NIDEK AFC-230:
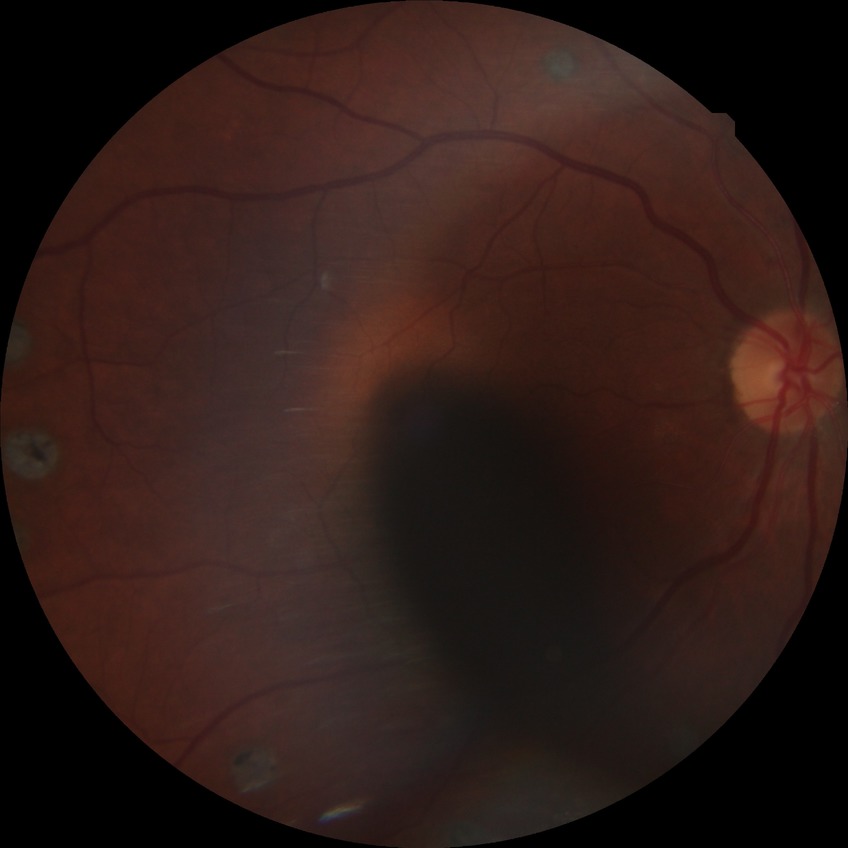
Diabetic retinopathy (DR): proliferative diabetic retinopathy (PDR).